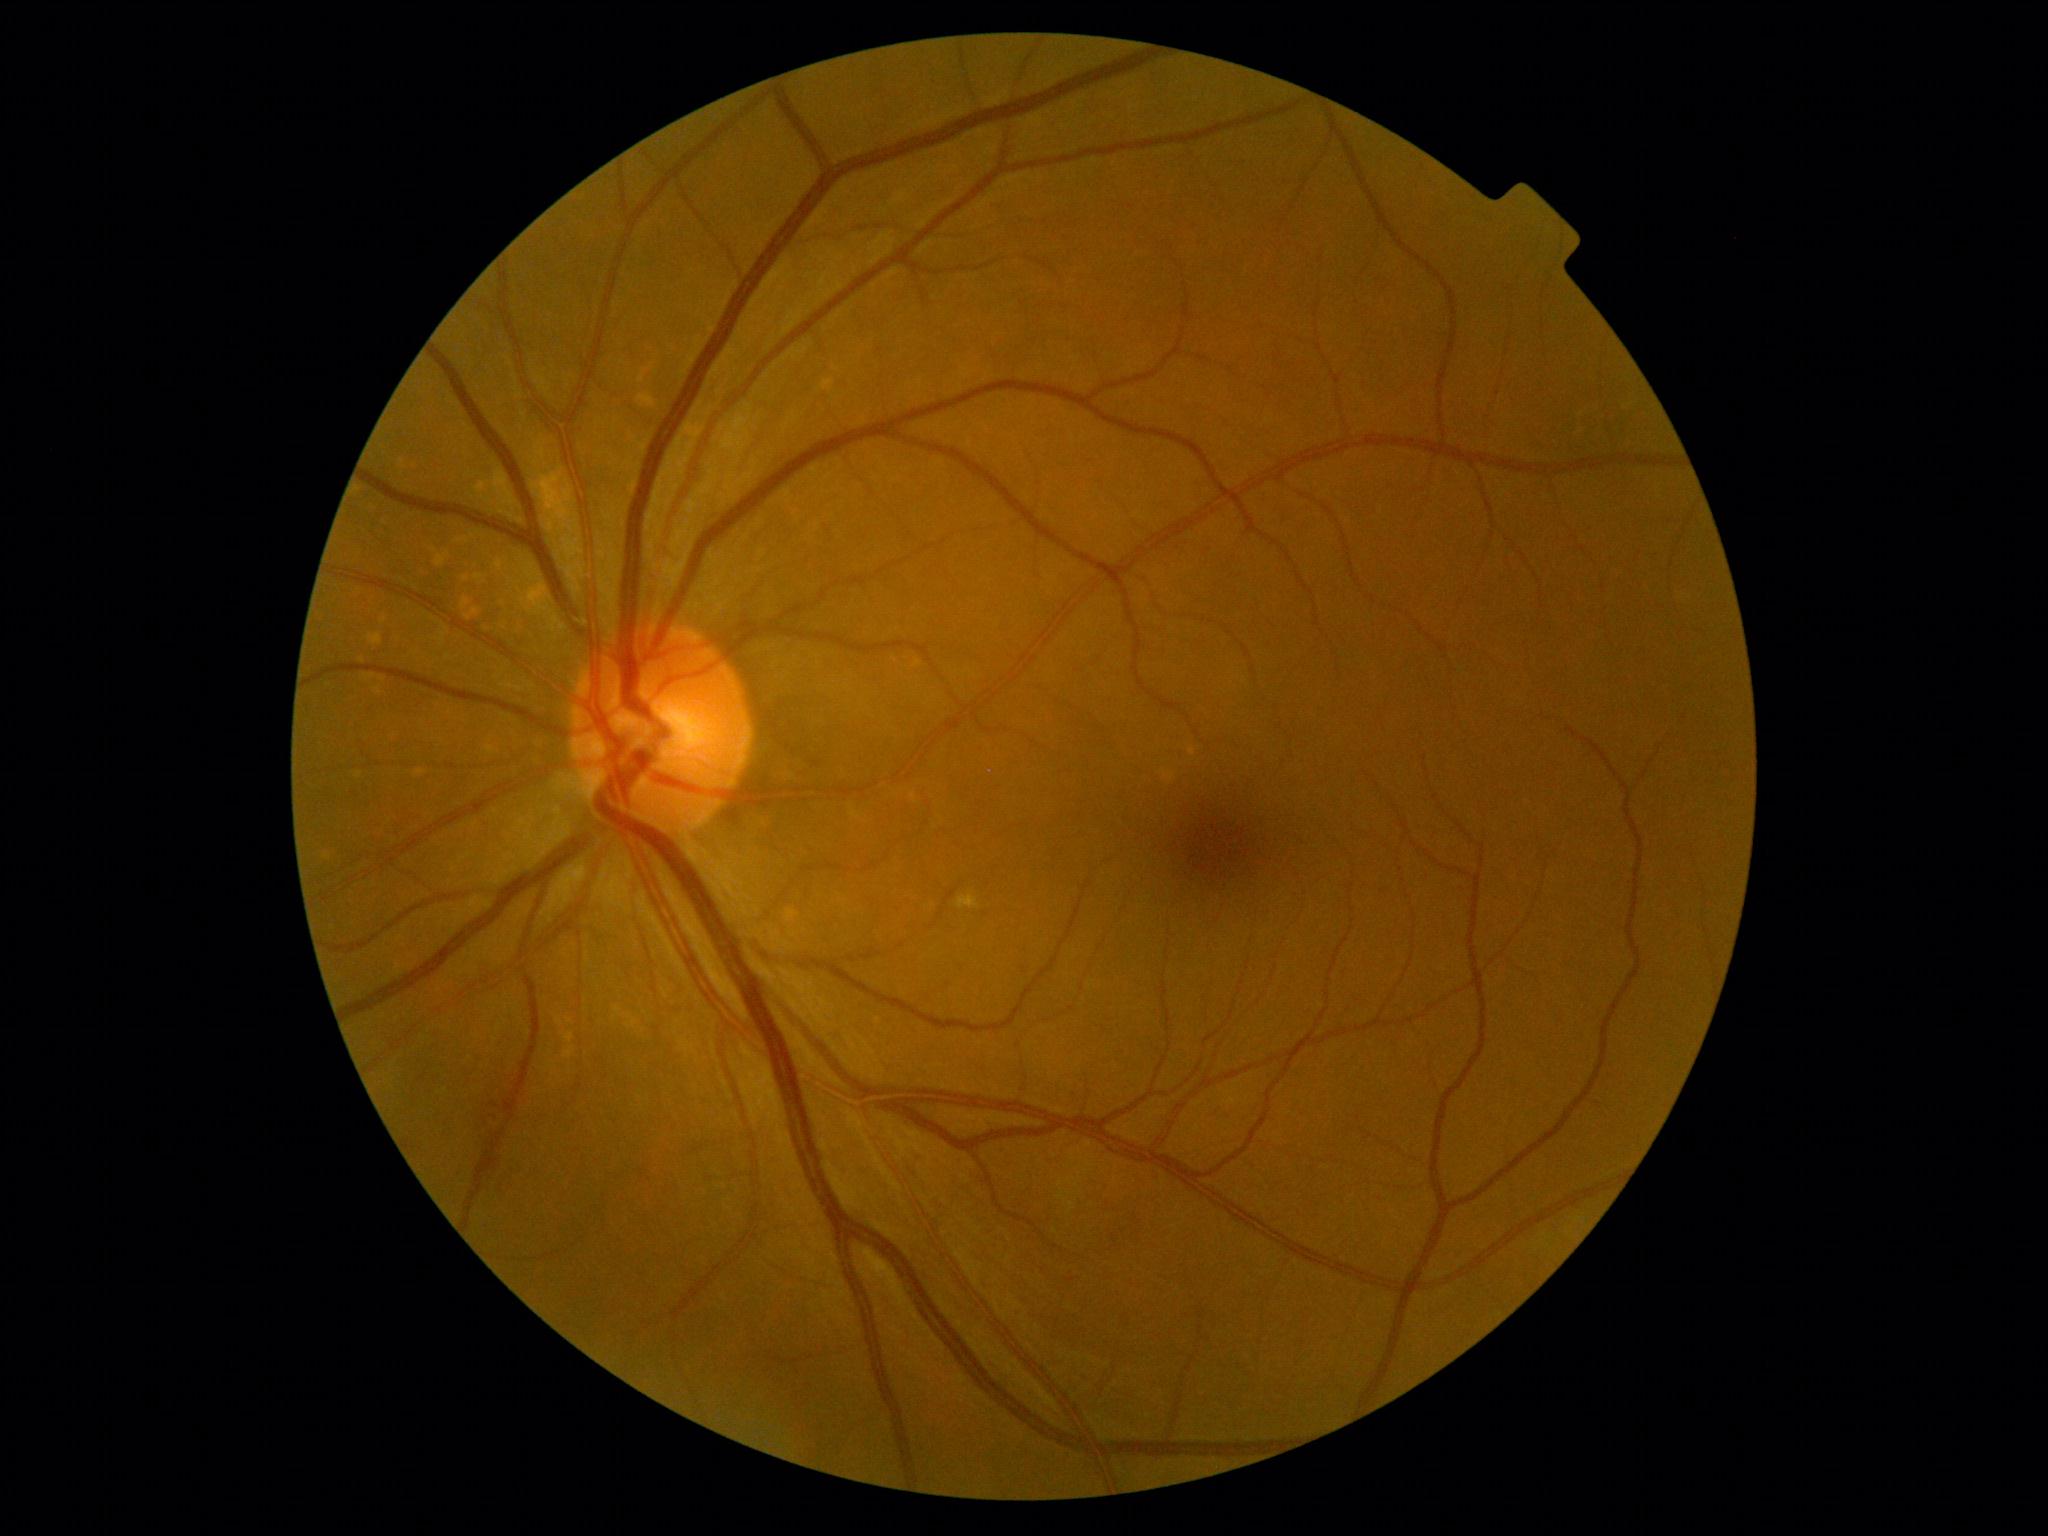 Diabetic retinopathy (DR) is grade 0.
No DR findings.